Acquired on the Natus RetCam Envision. Pediatric wide-field fundus photograph. 1440x1080: 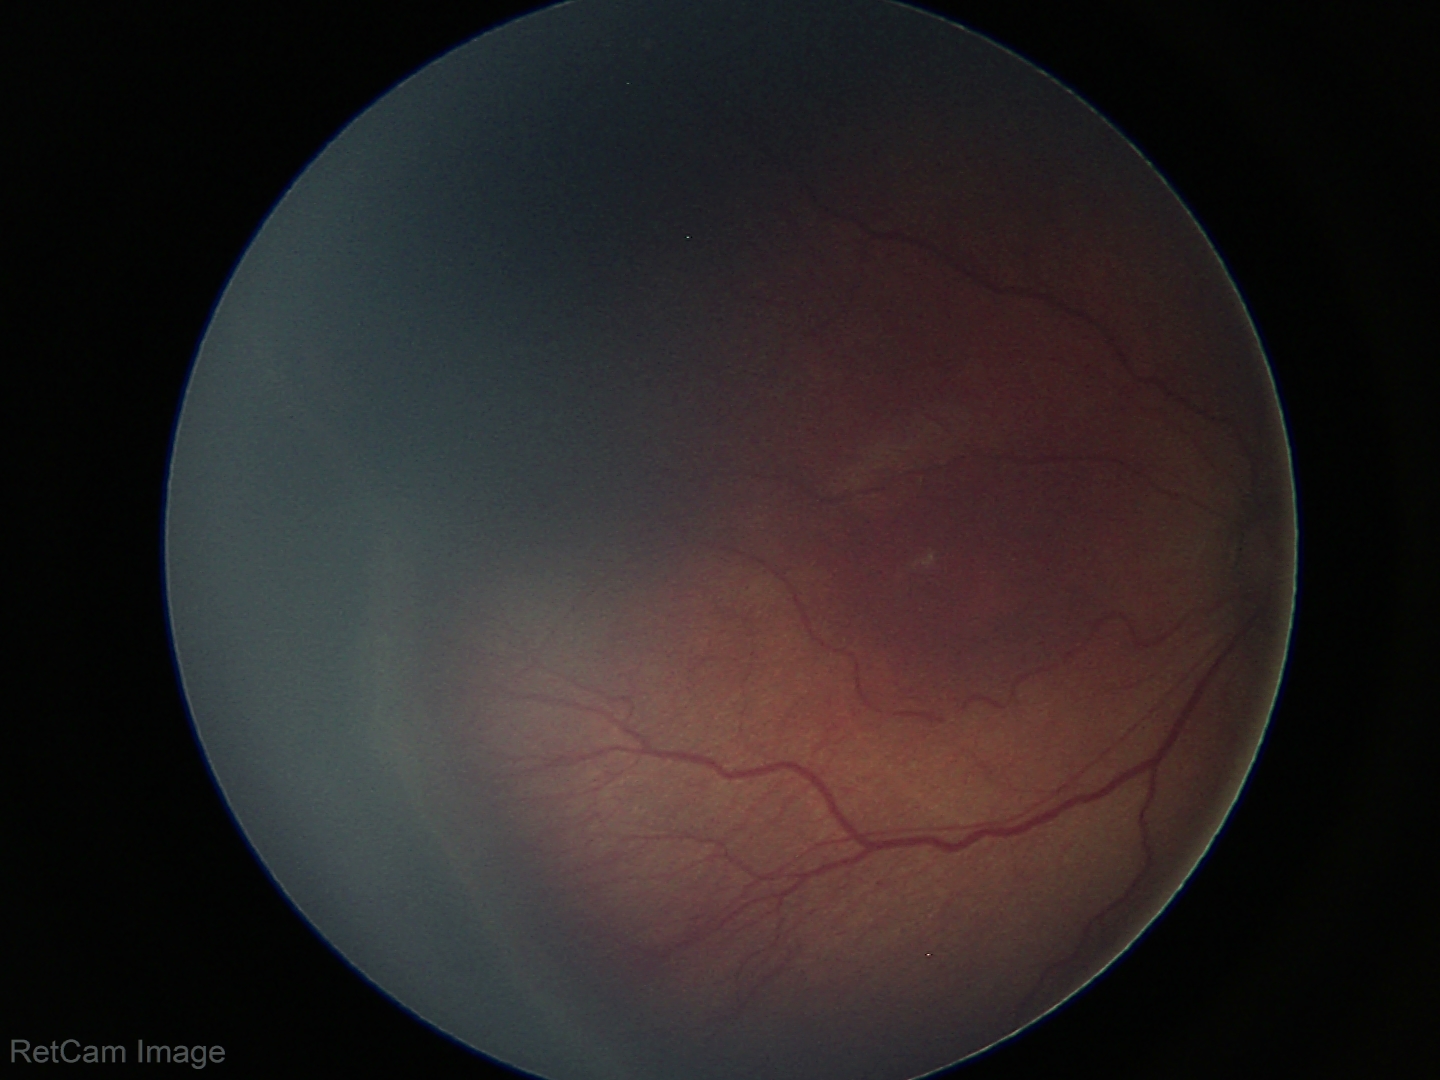 From an examination with diagnosis of ROP stage 3 — ridge with extraretinal fibrovascular proliferation.